Natus RetCam Envision, 130° FOV; wide-field contact fundus photograph of an infant; 1440x1080px.
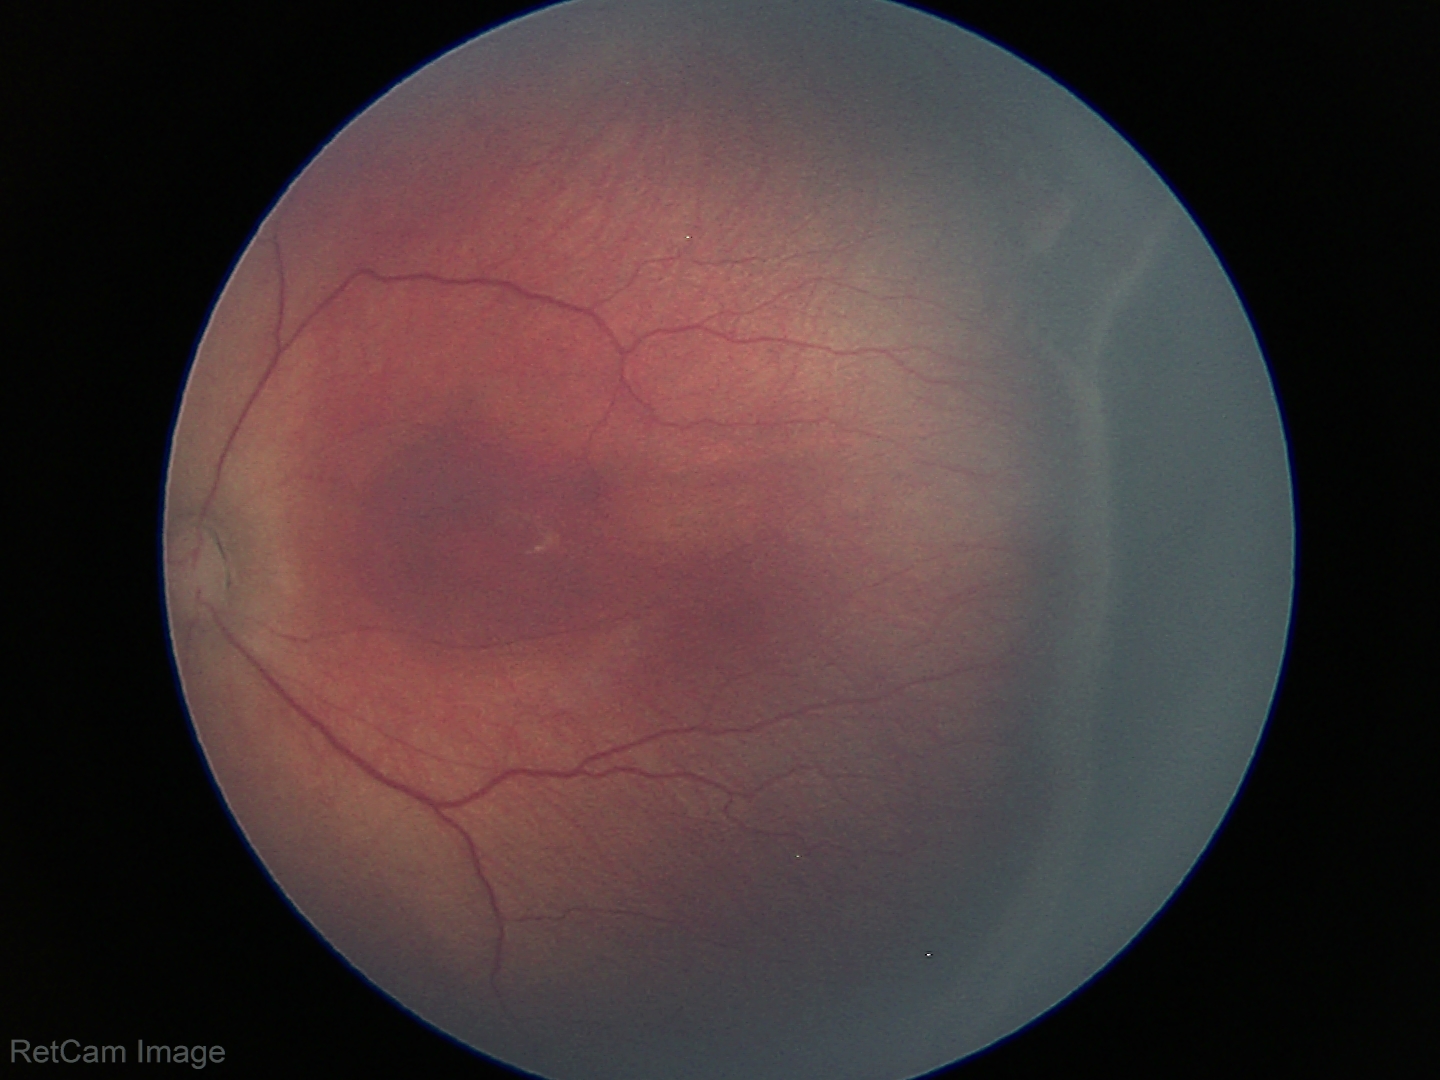 Diagnosis from this screening exam: retinopathy of prematurity stage 3.
No plus disease.